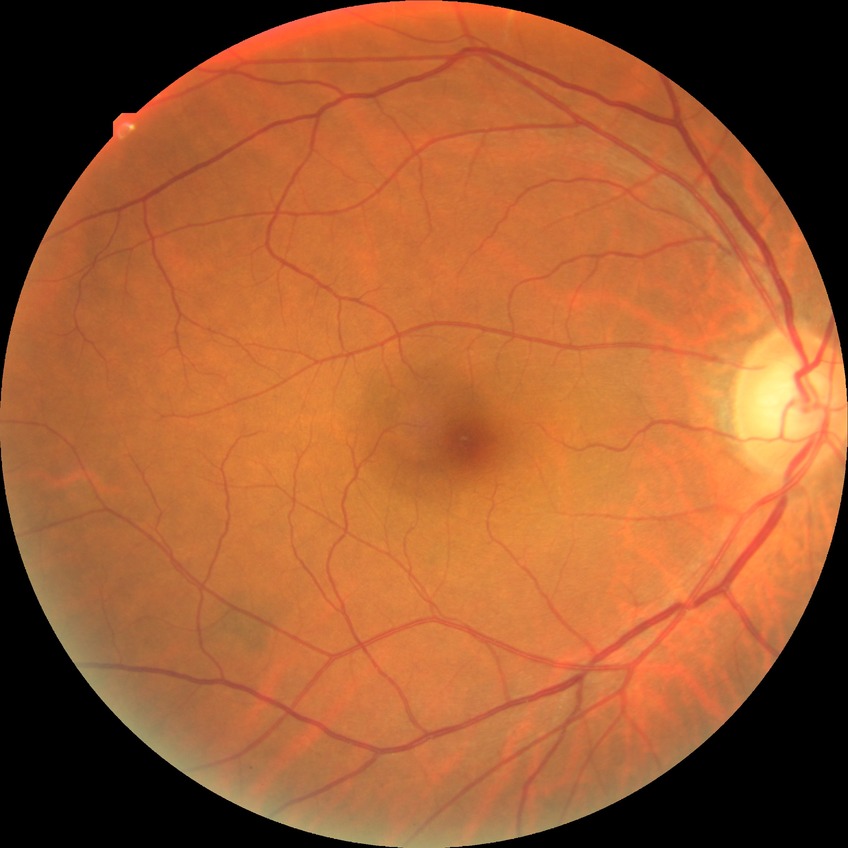
Diabetic retinopathy (DR) is no diabetic retinopathy (NDR).